848x848px · diabetic retinopathy graded by the modified Davis classification — 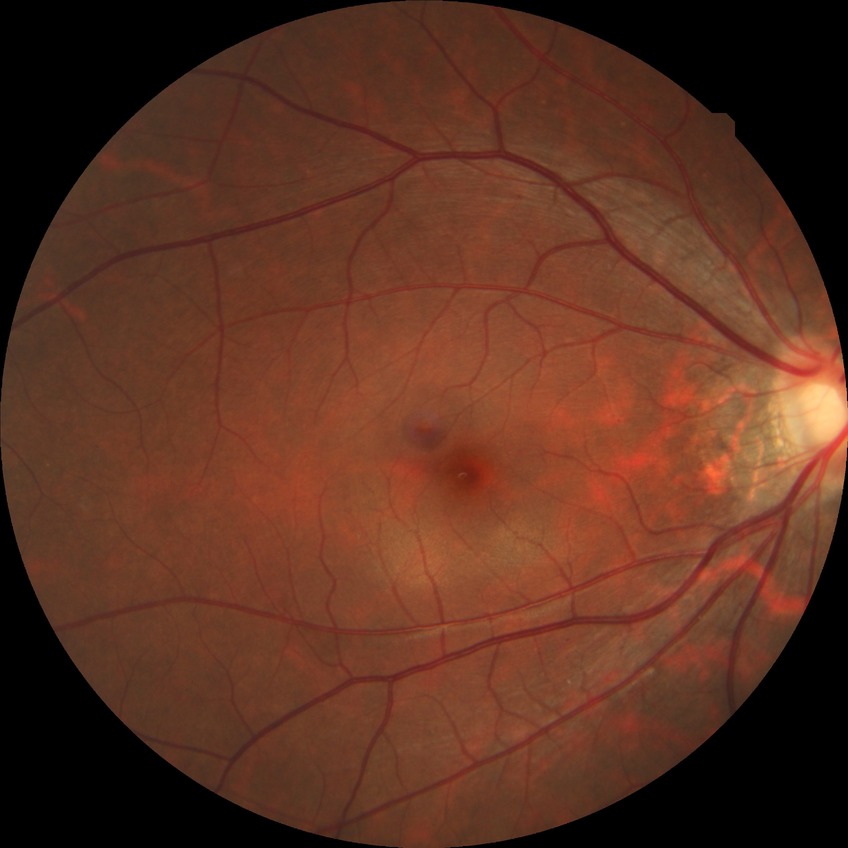 DR severity: SDR.